50 years old.
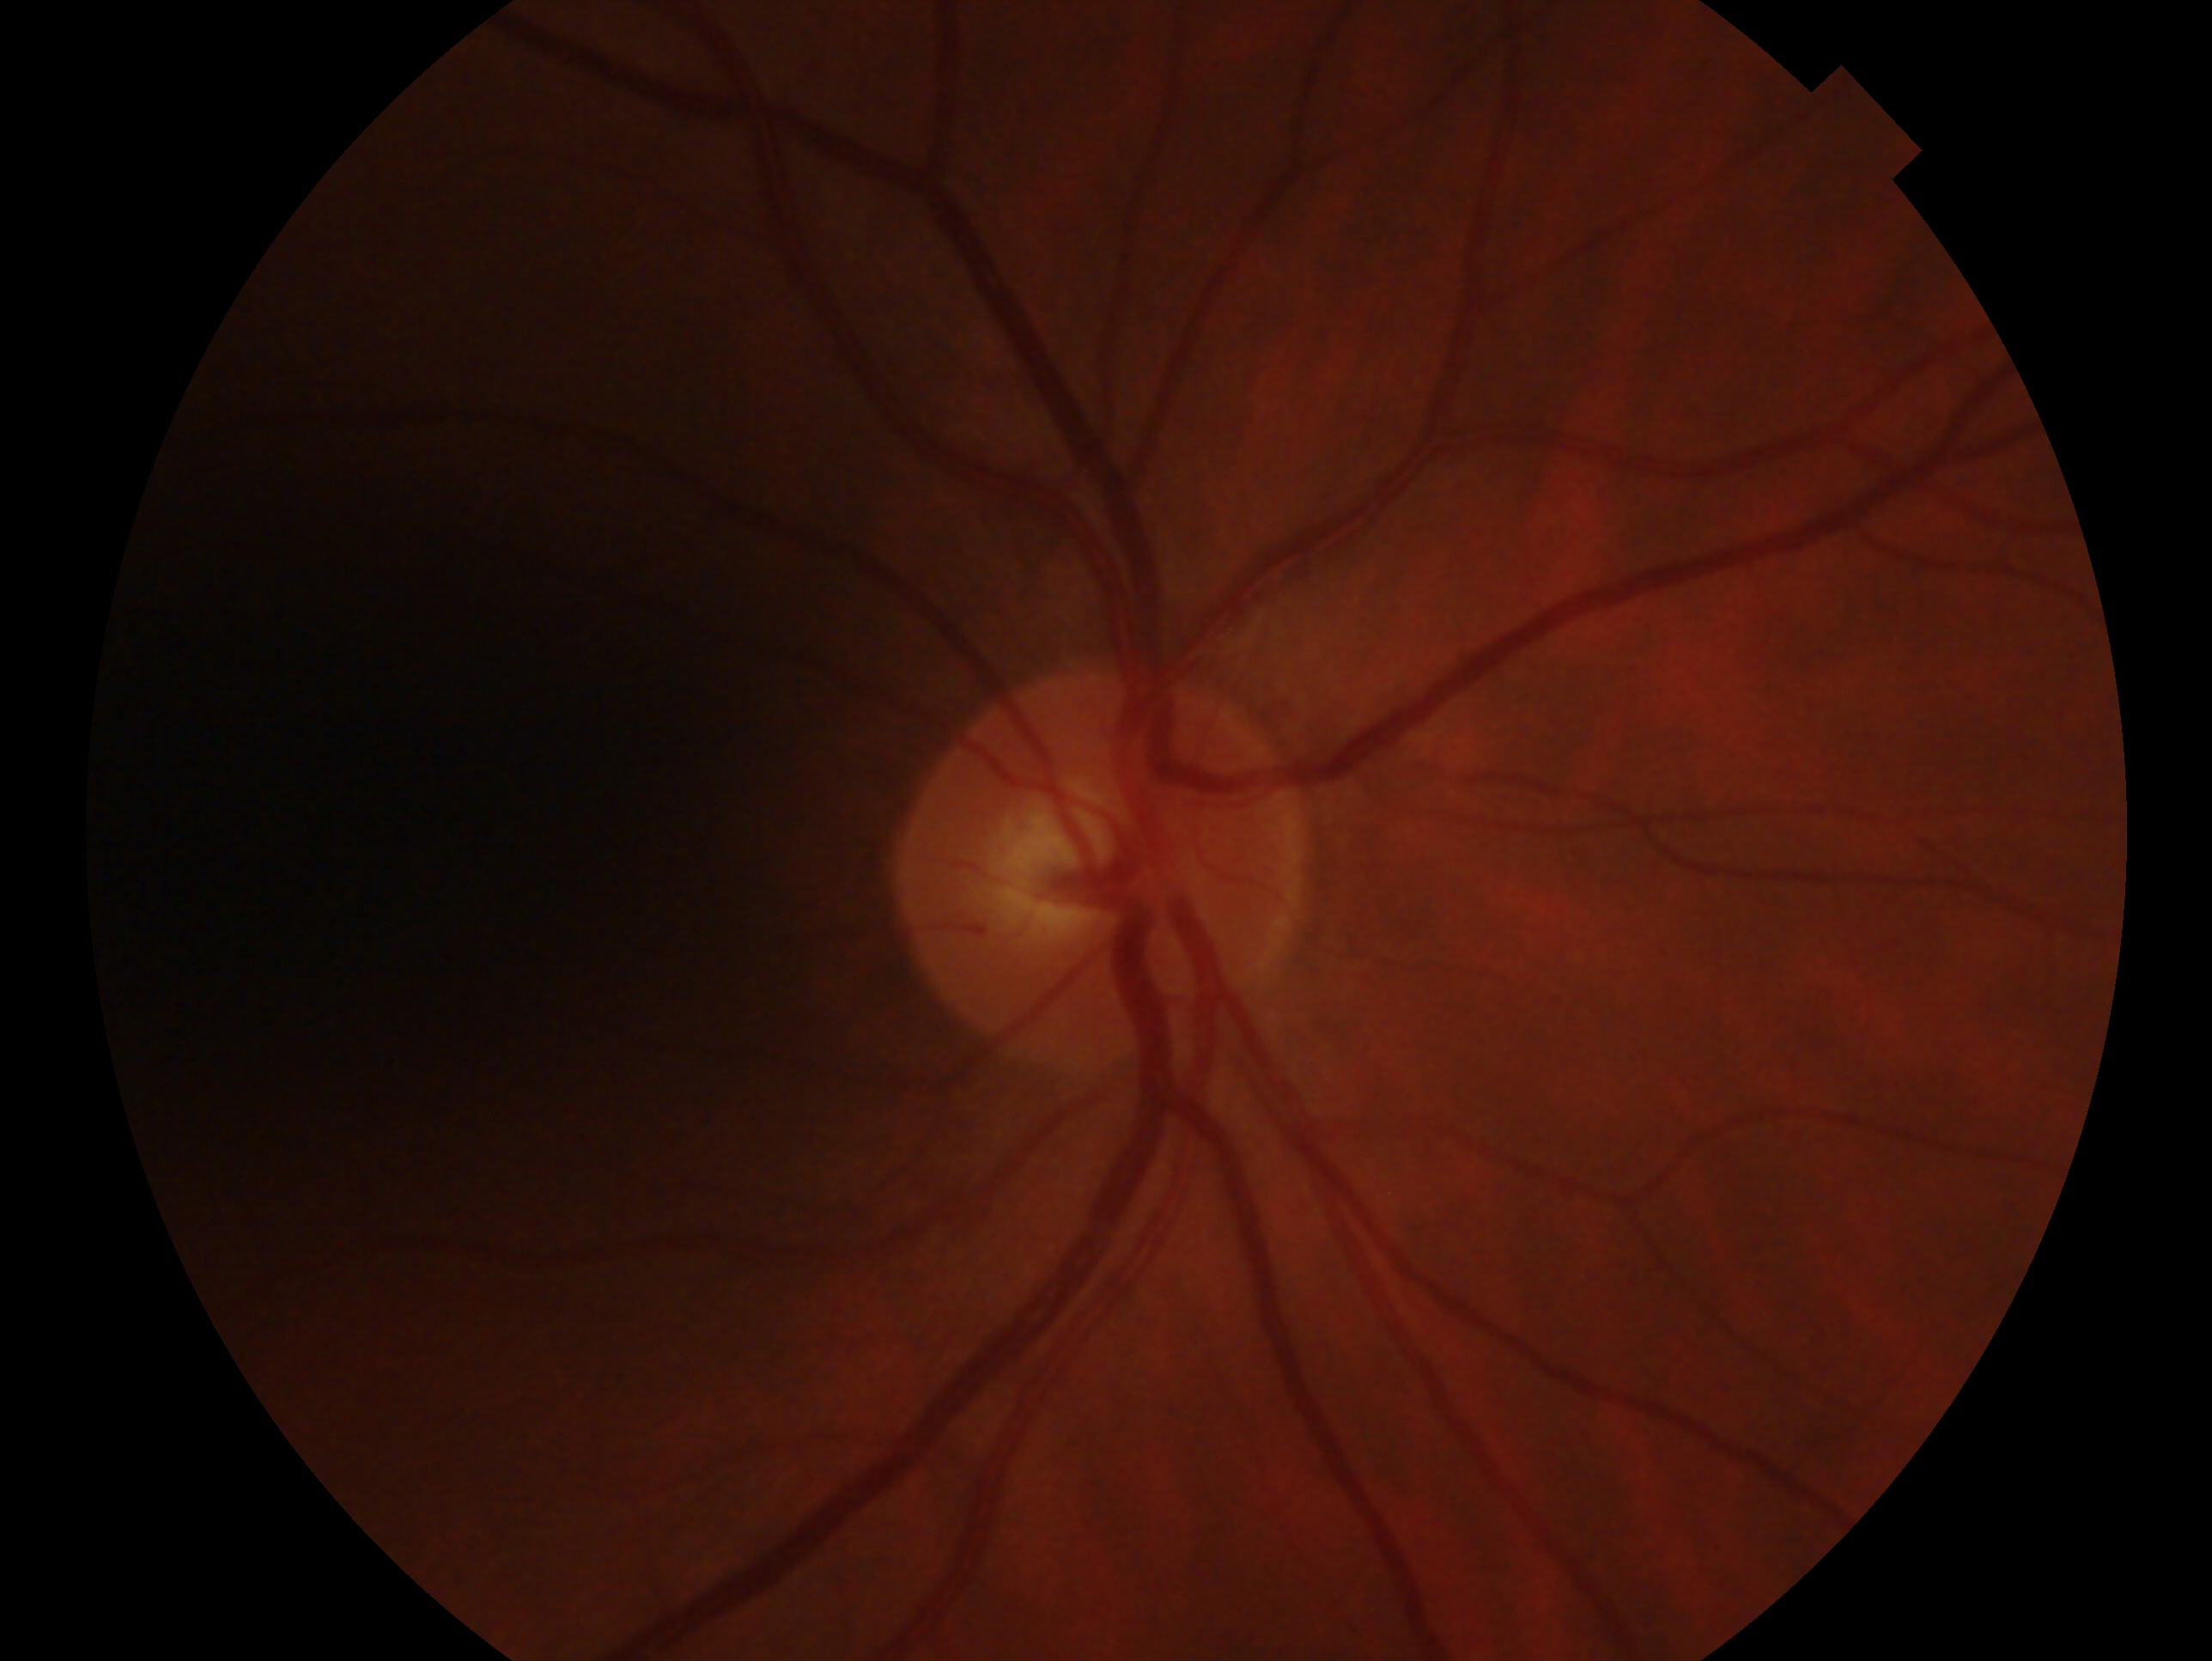 laterality: oculus dexter | diagnosis: no glaucoma.